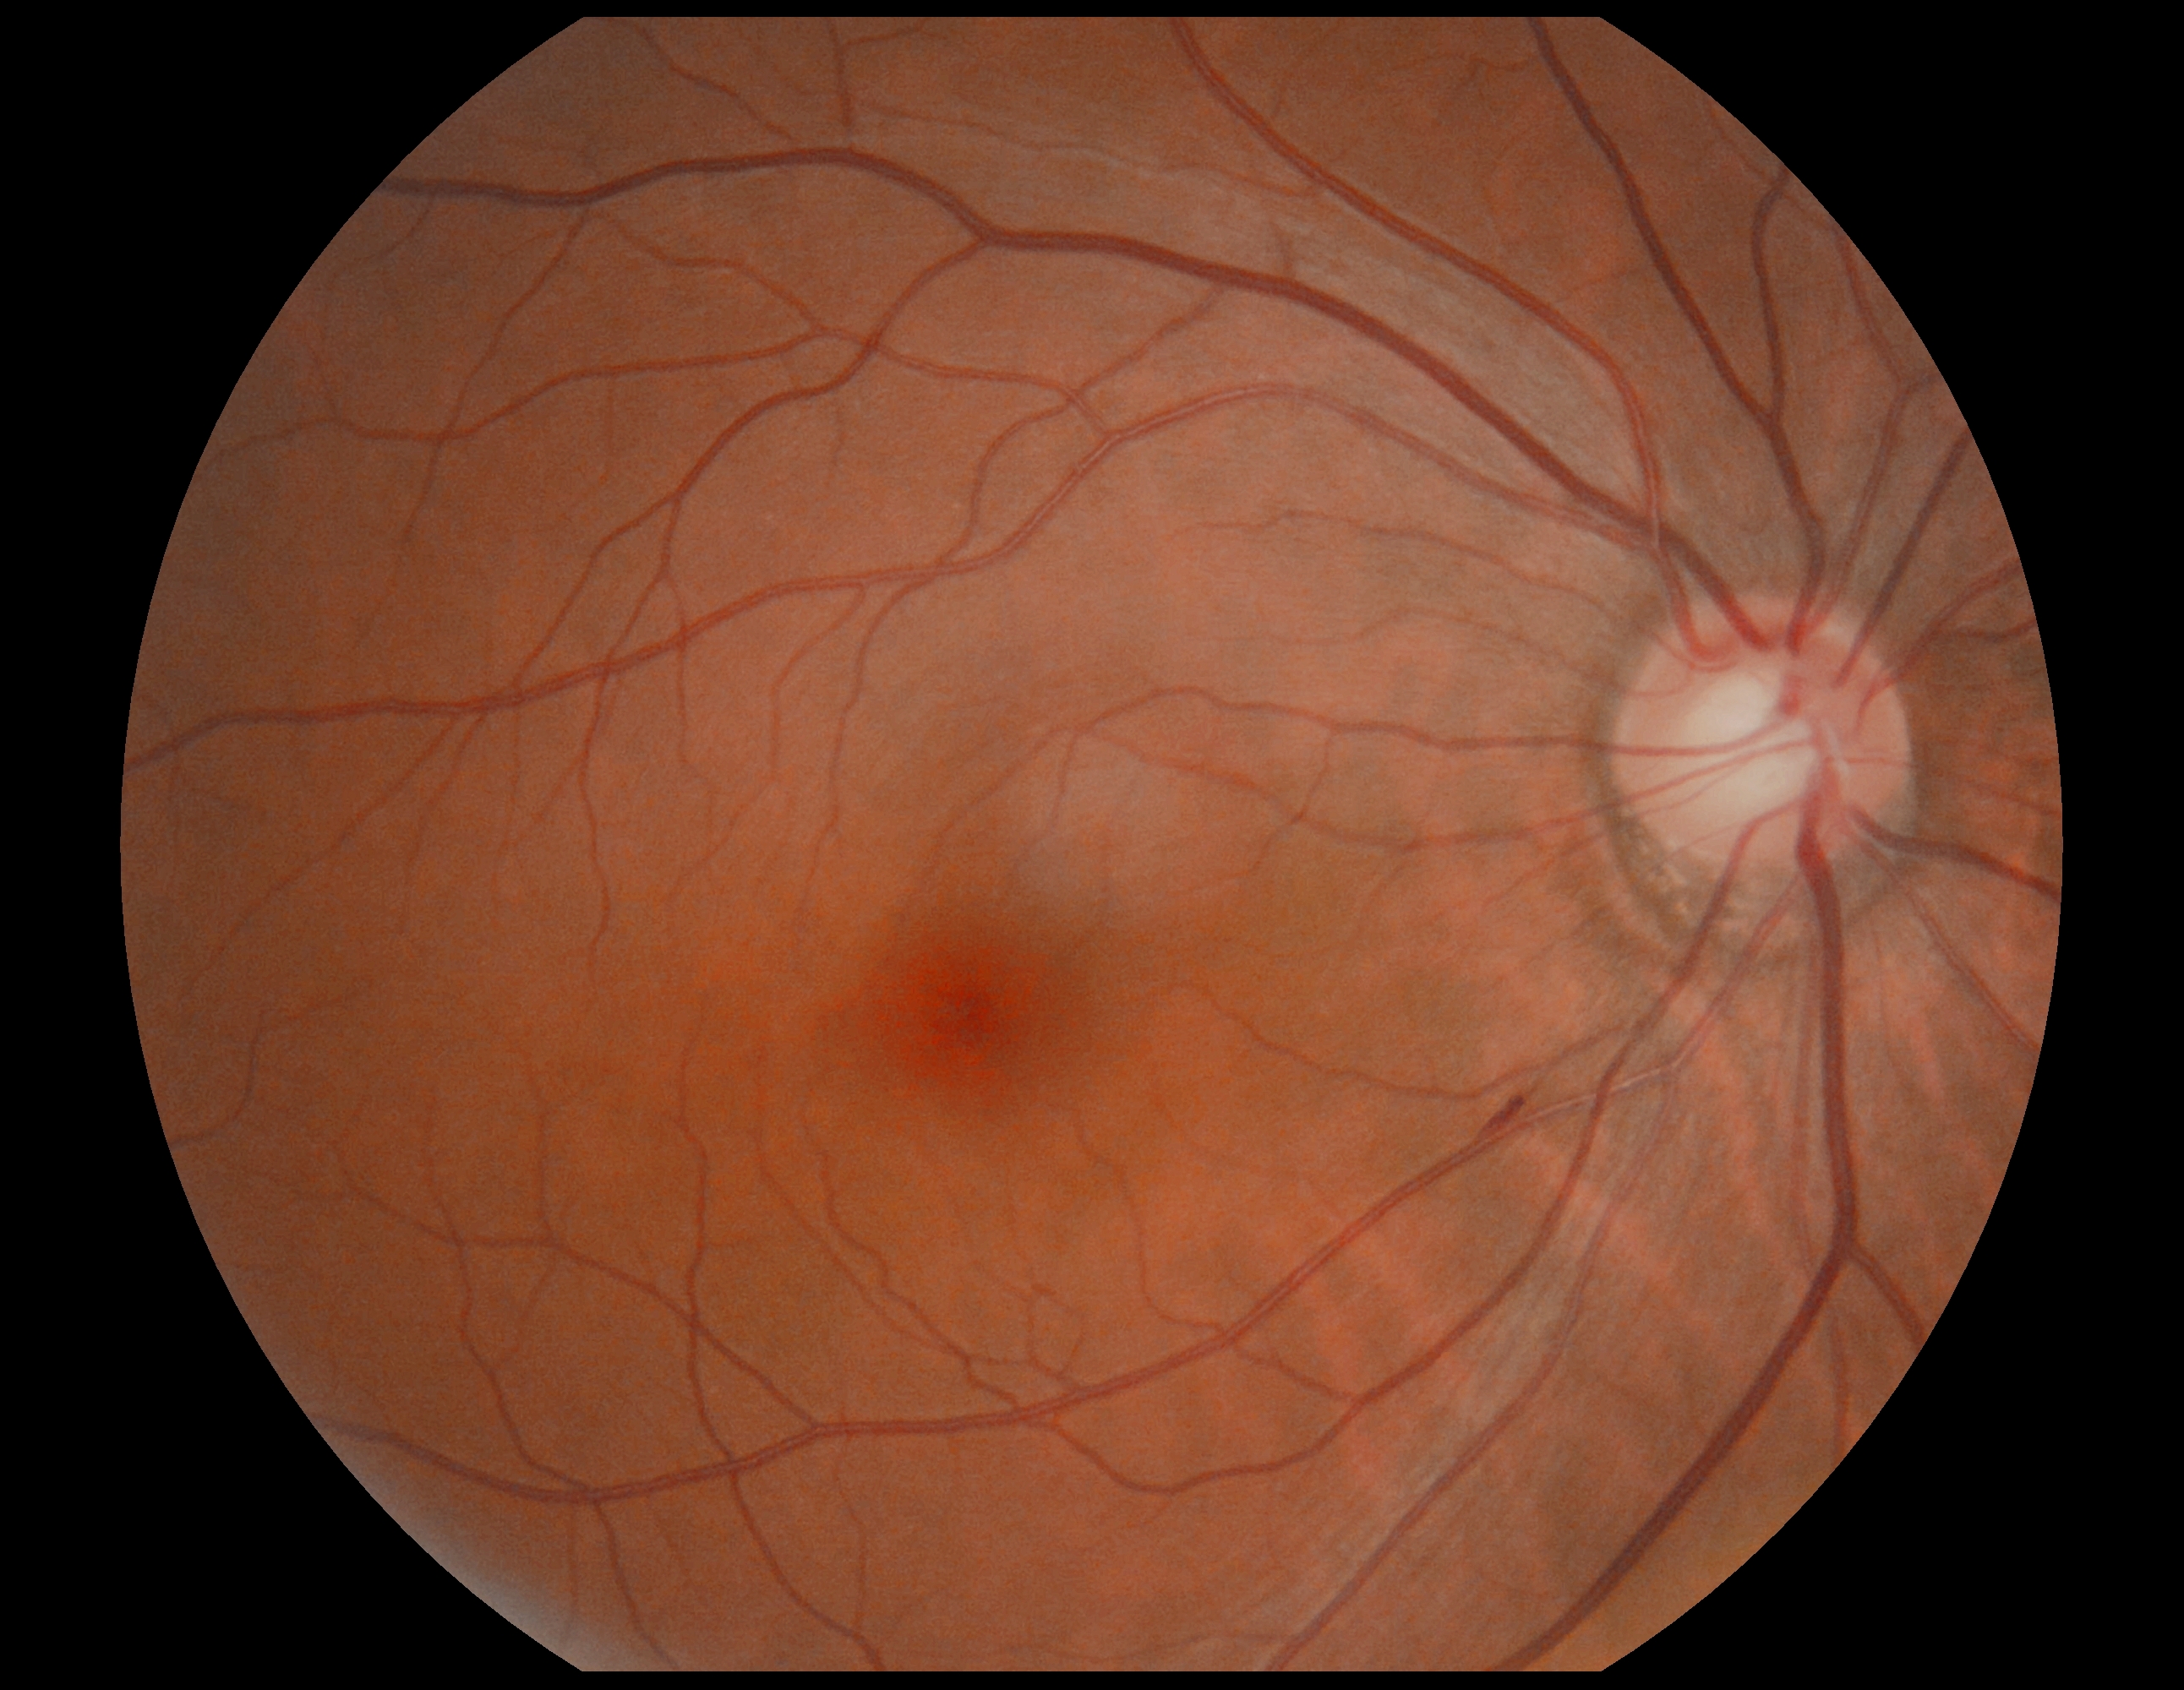 Diabetic retinopathy (DR): moderate NPDR (grade 2) — more than just microaneurysms but less than severe NPDR.